Tabletop color fundus camera image
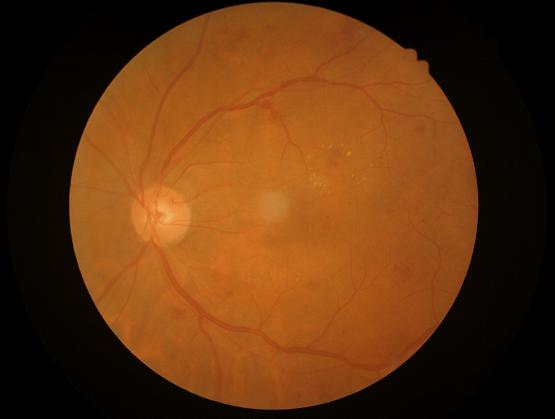
Overall quality is good and the image is gradable. Contrast is good. No noticeable blur.